1240 by 1240 pixels · wide-field contact fundus photograph of an infant.
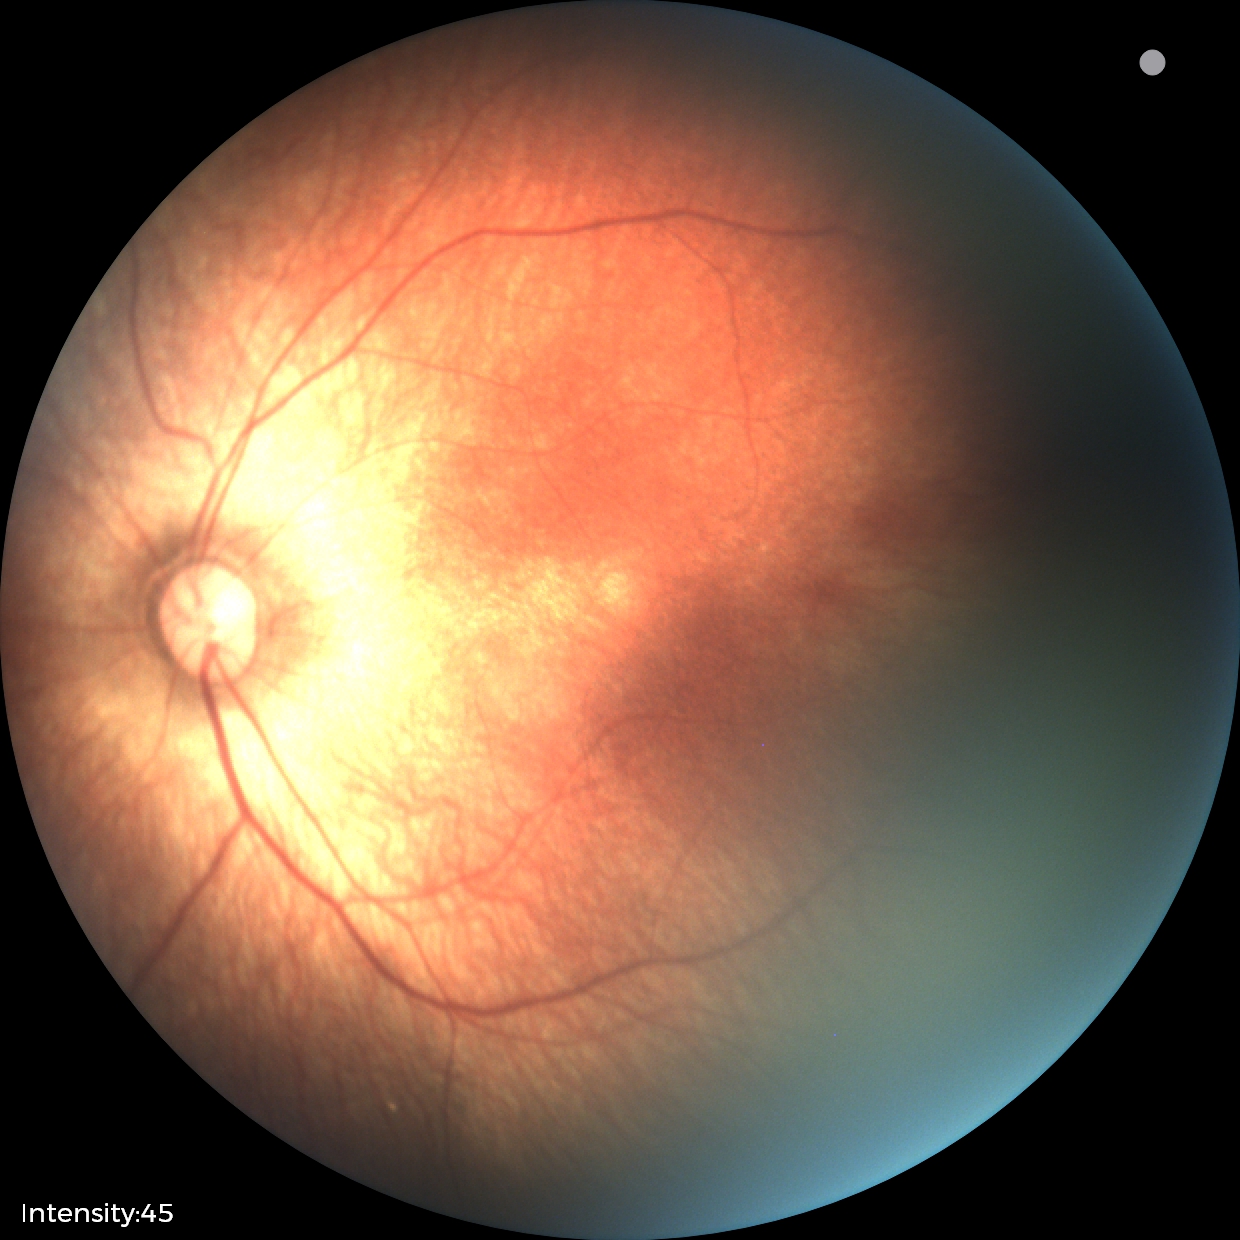 Normal screening examination.